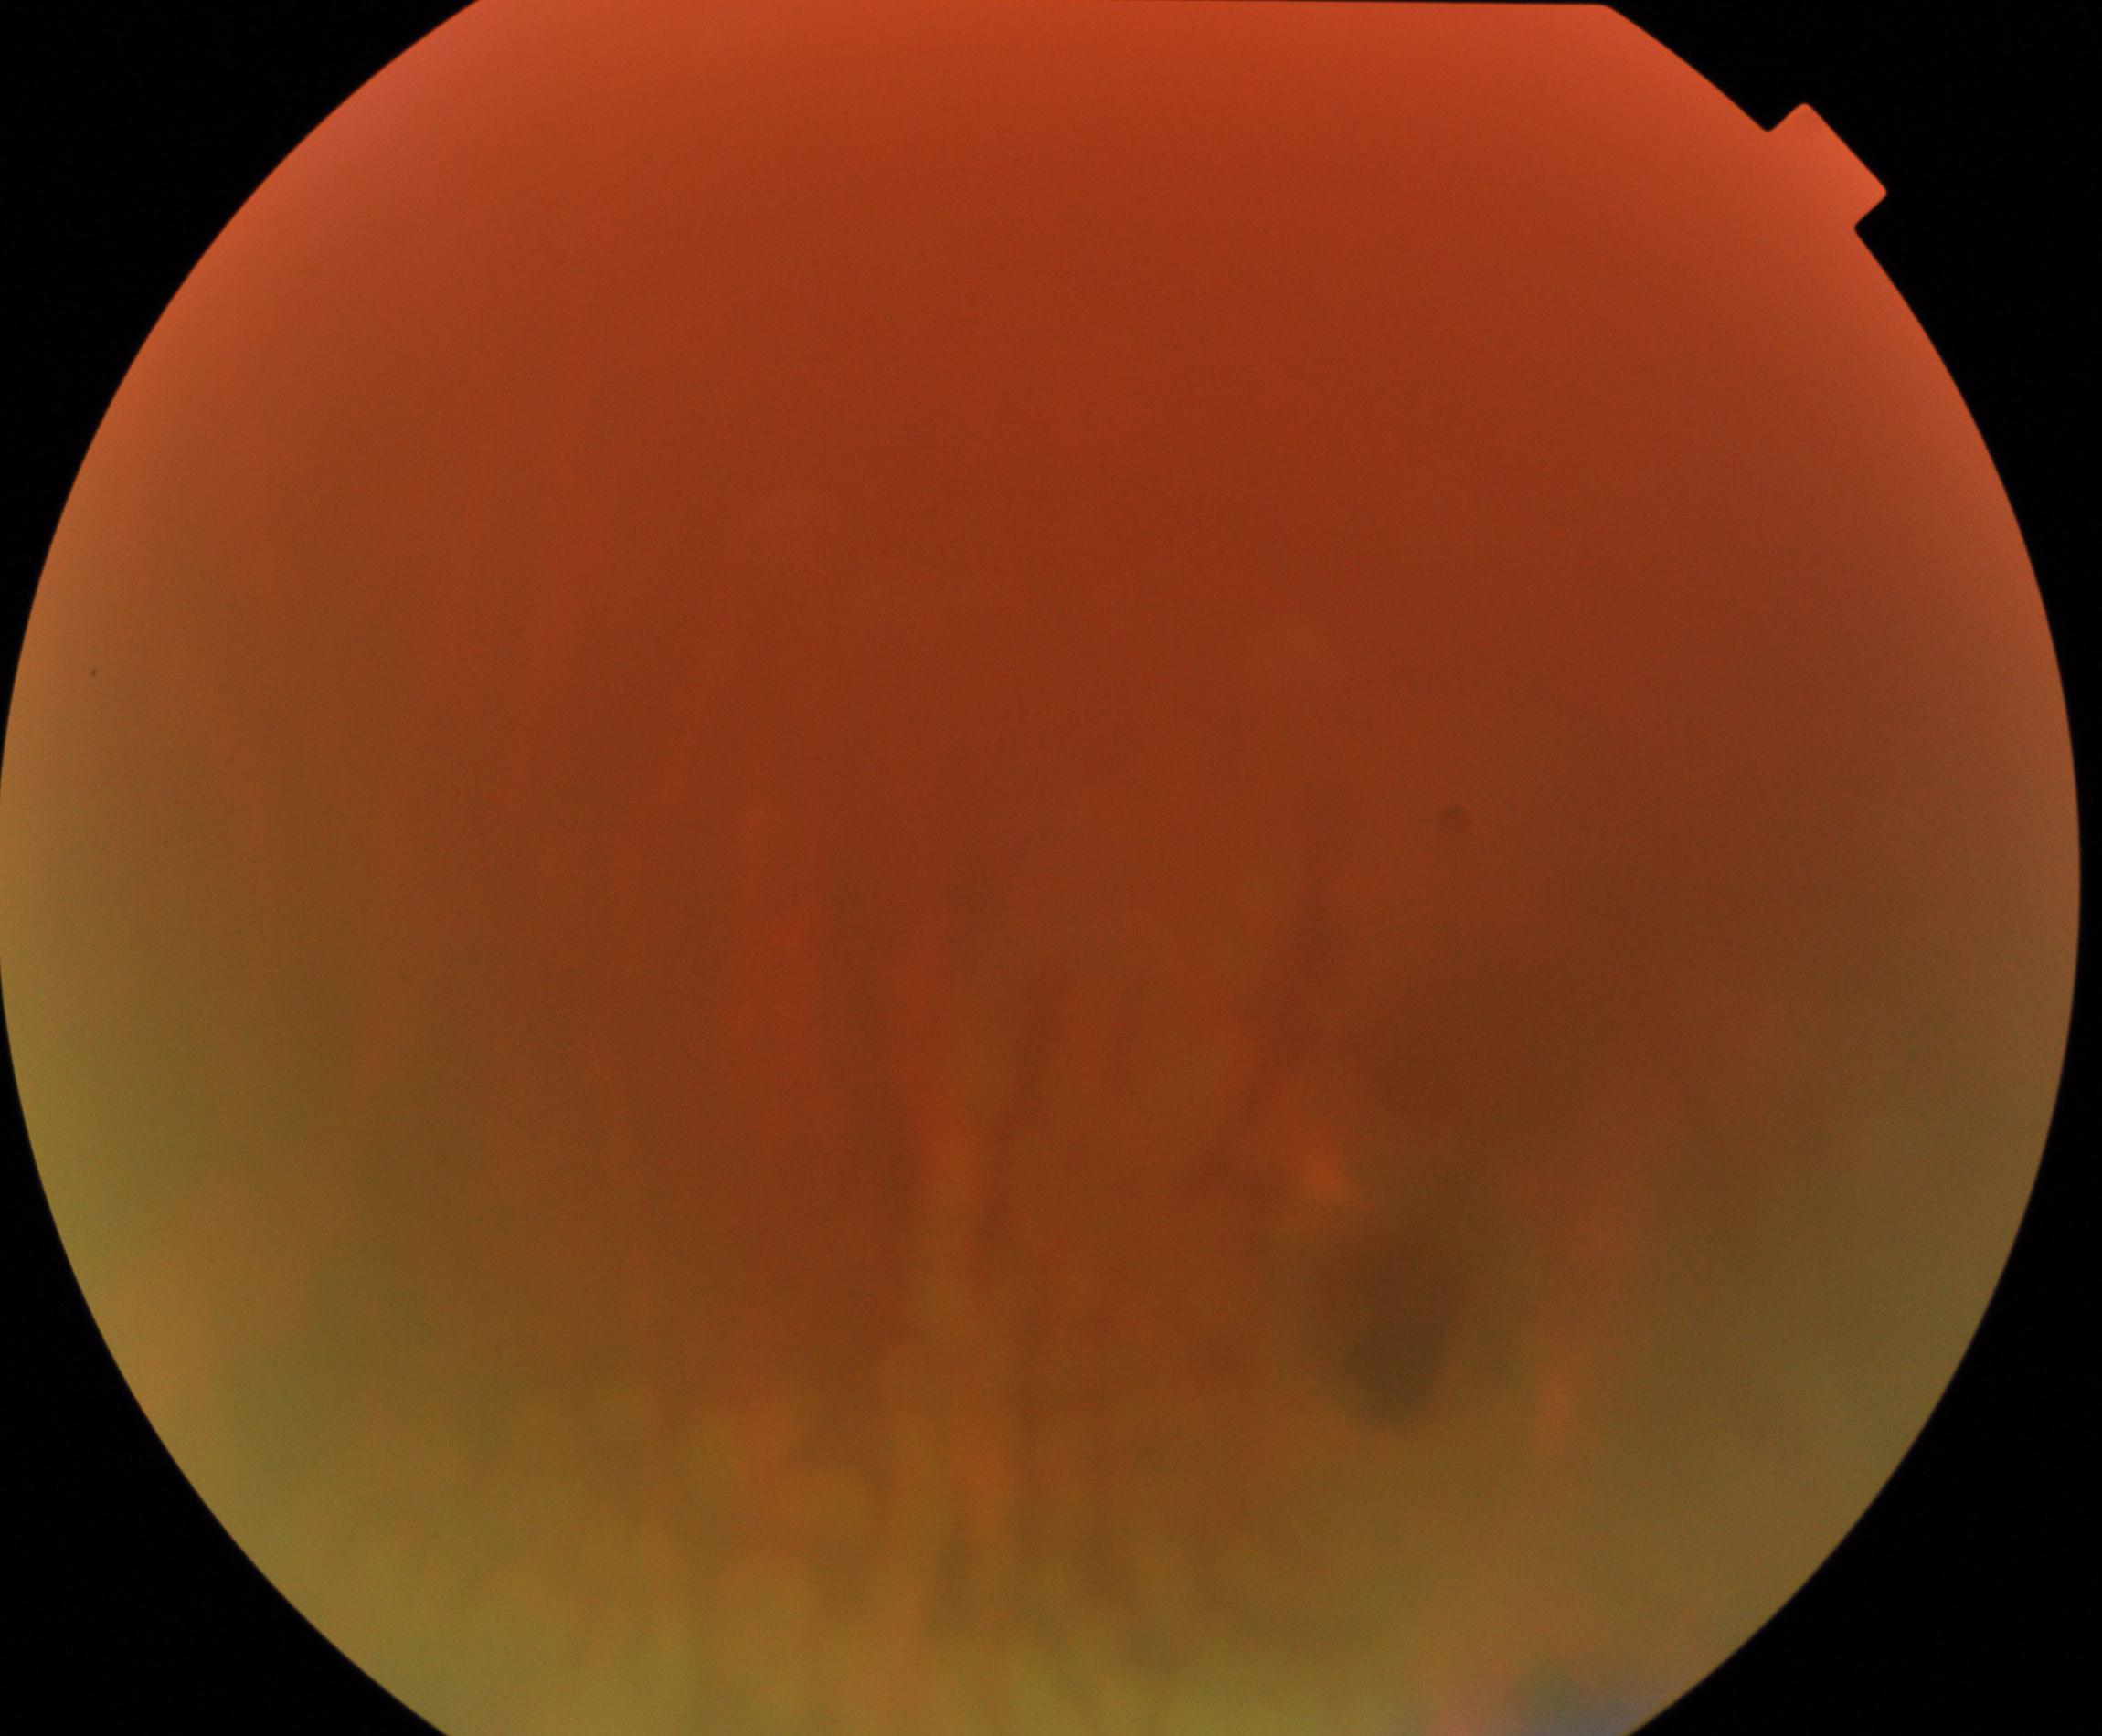

Blurred fundus image with substantial obscuration of retinal landmarks. Proliferative diabetic retinopathy not identified in the visible portion.